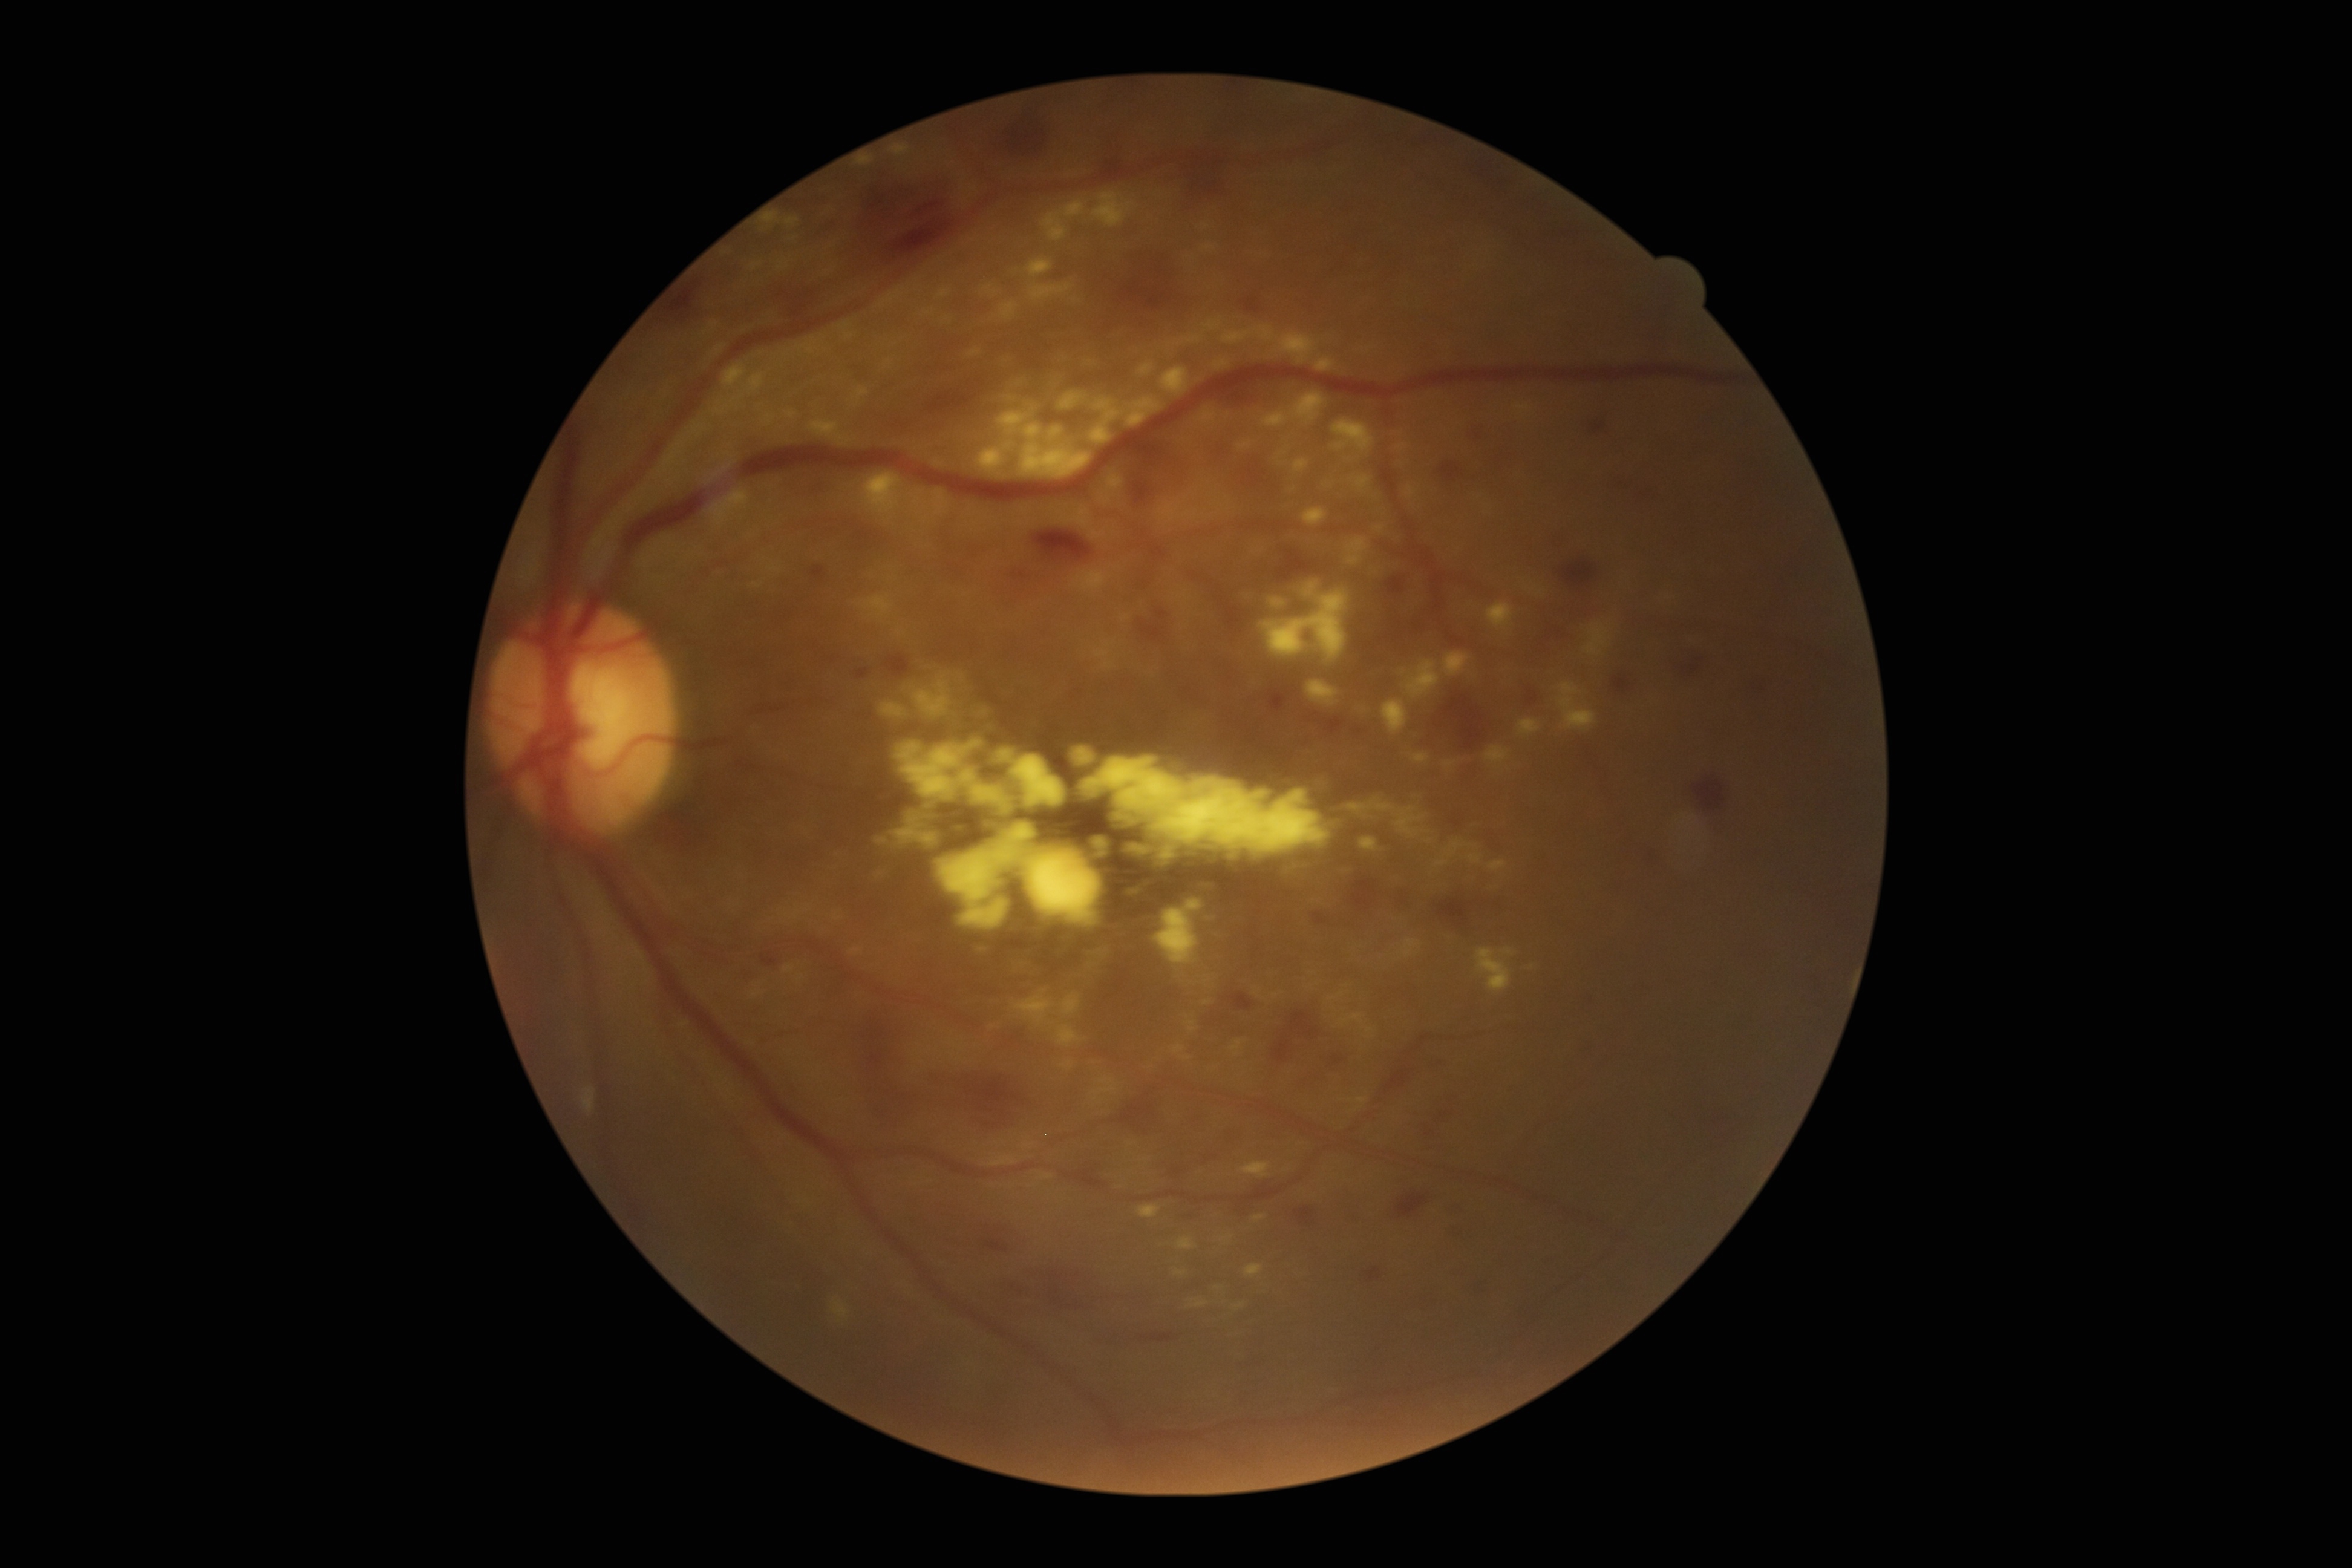
diabetic retinopathy severity = 3/4.